Image size 848x848, camera: NIDEK AFC-230 — 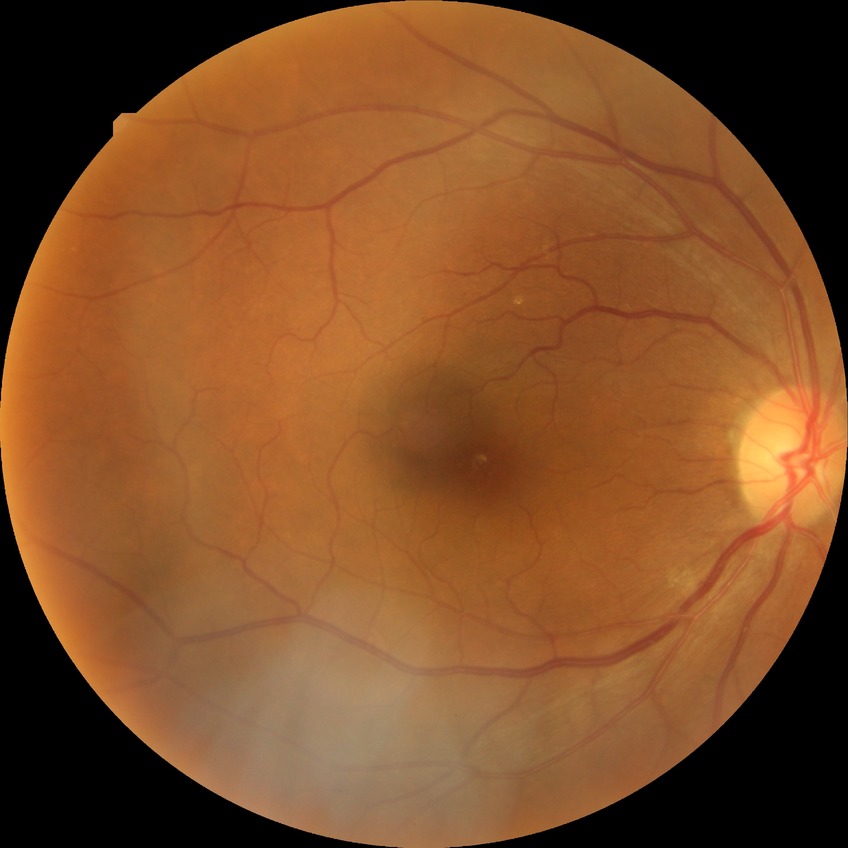

{
  "davis_grade": "NDR (no diabetic retinopathy)"
}